45° field of view. 2352x1568px. Color fundus photograph — 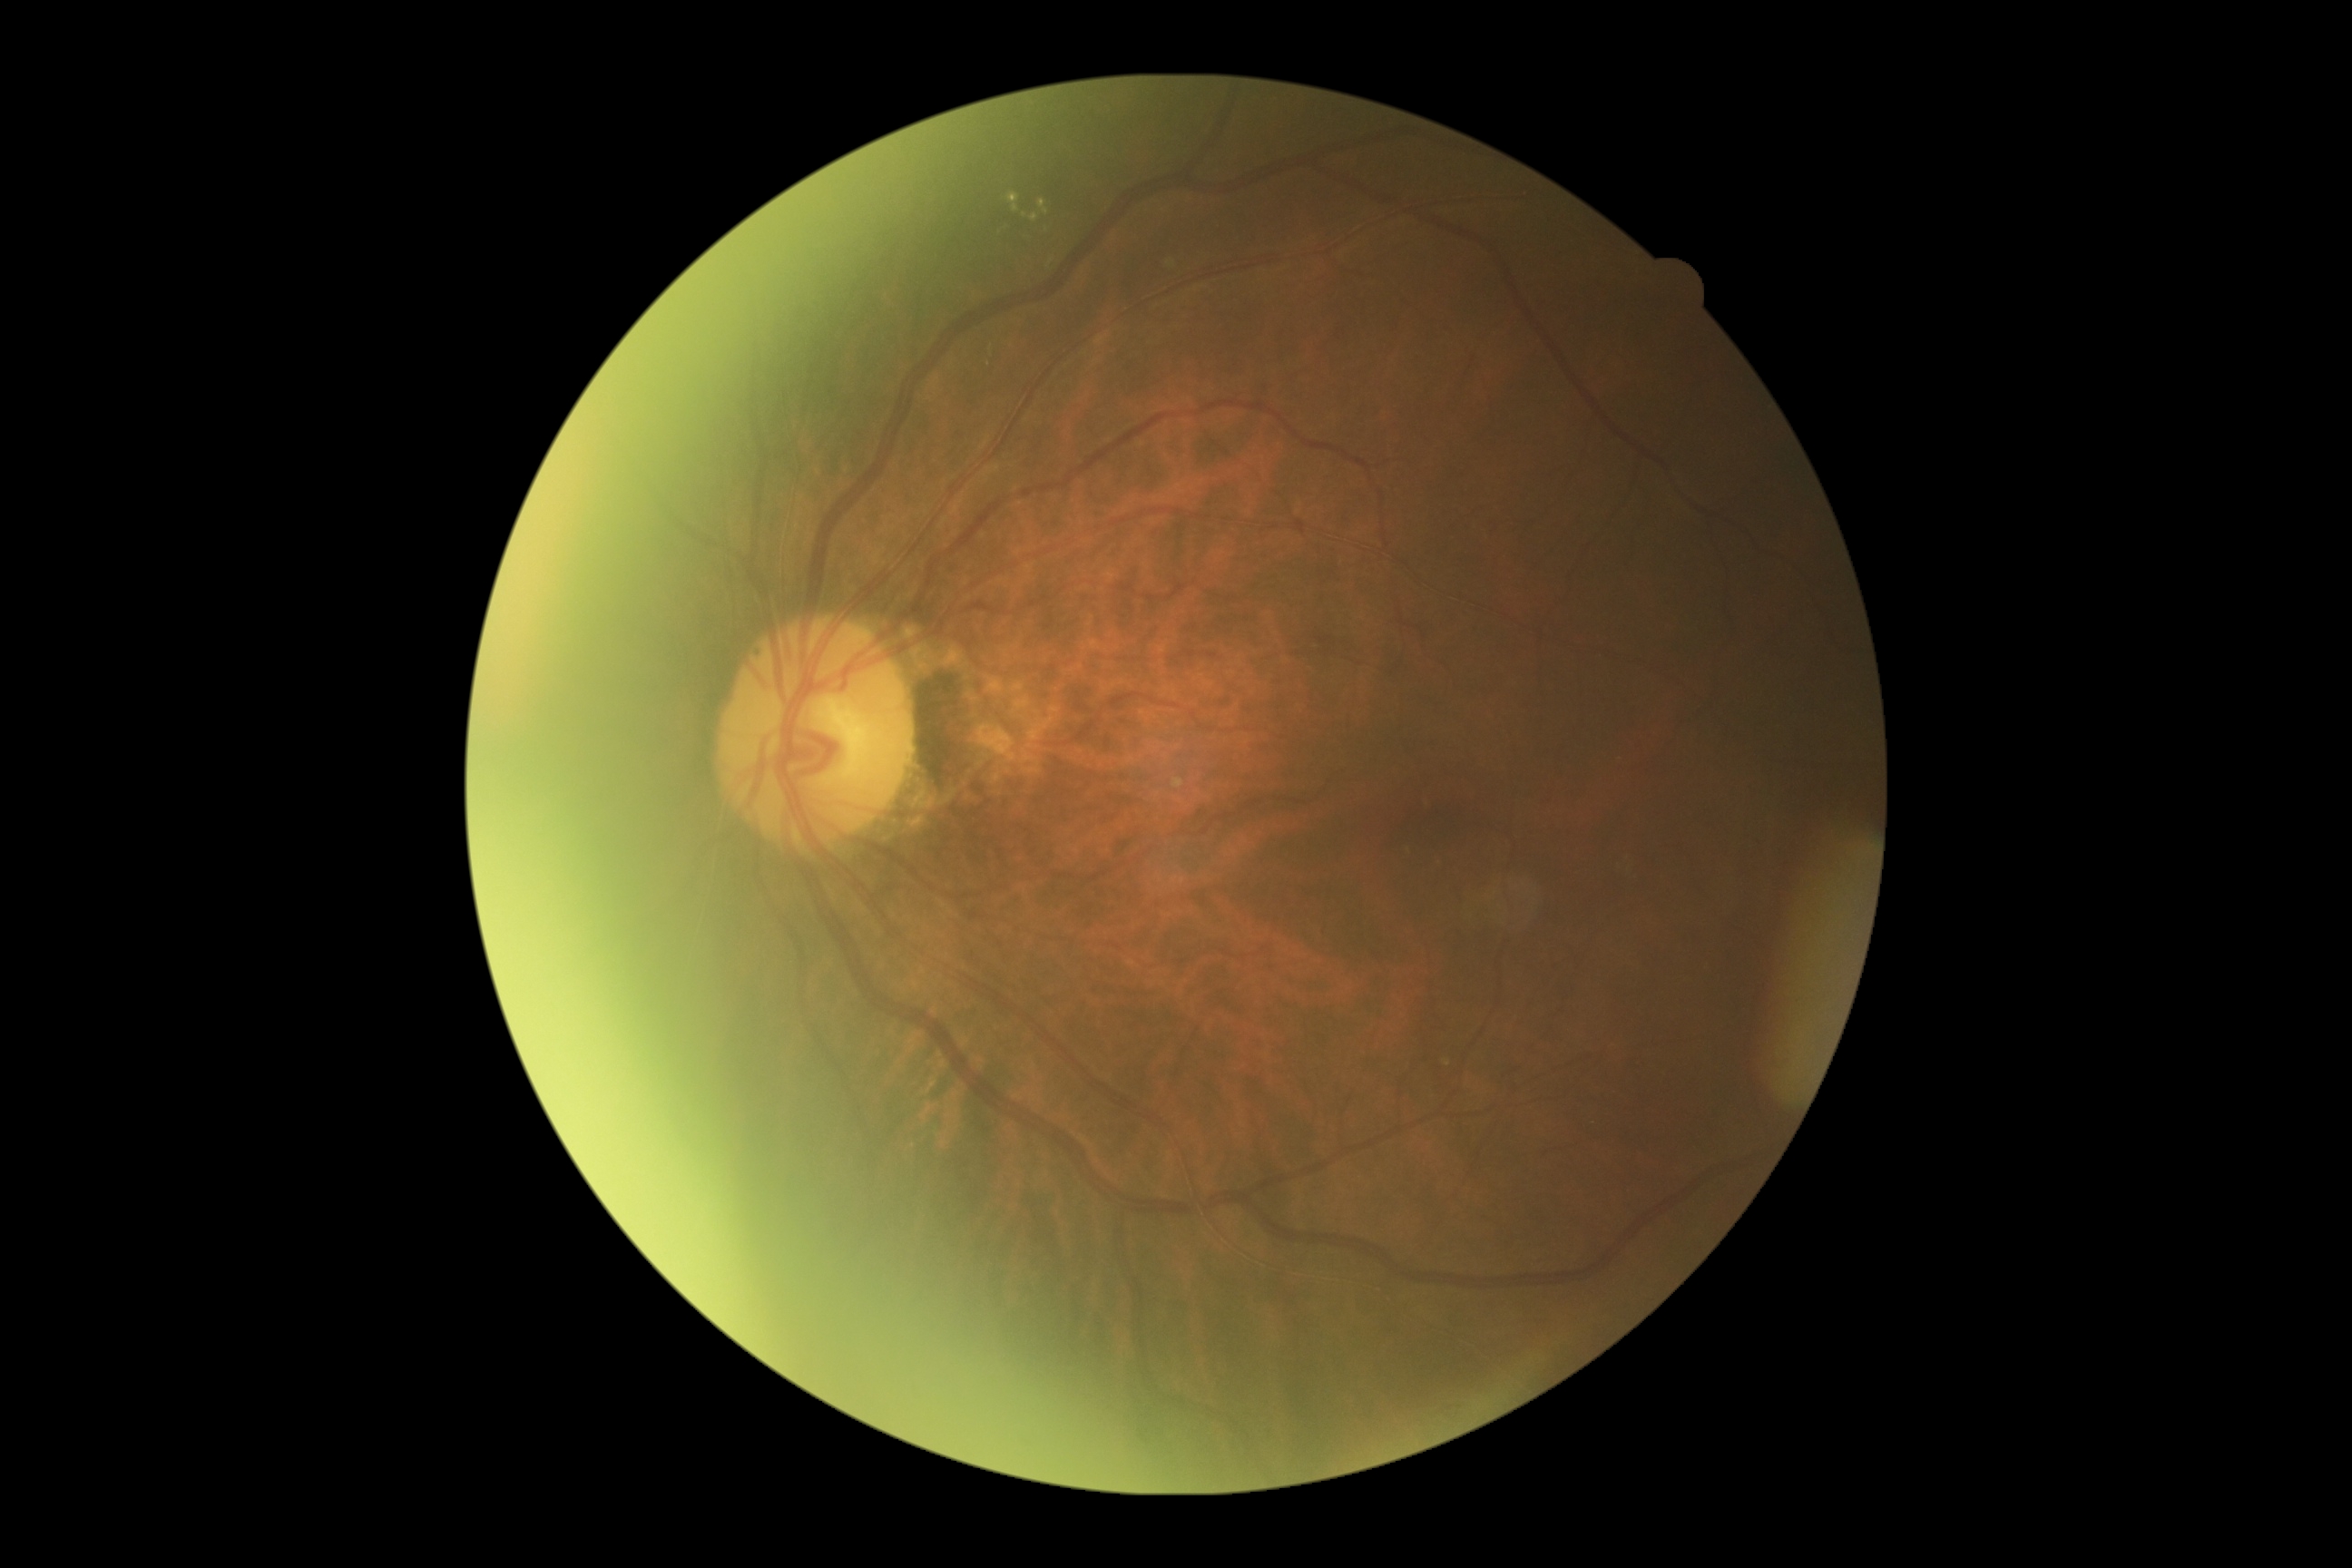 Diabetic retinopathy severity is moderate NPDR (grade 2).